Modified Davis classification — 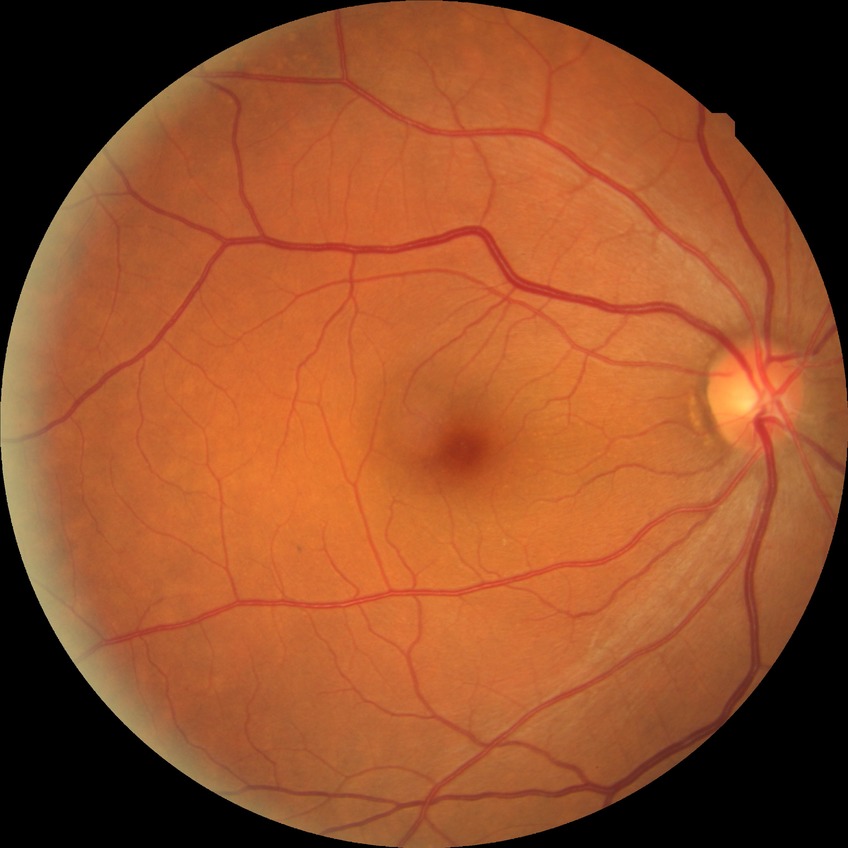

Diabetic retinopathy (DR) is no diabetic retinopathy (NDR).